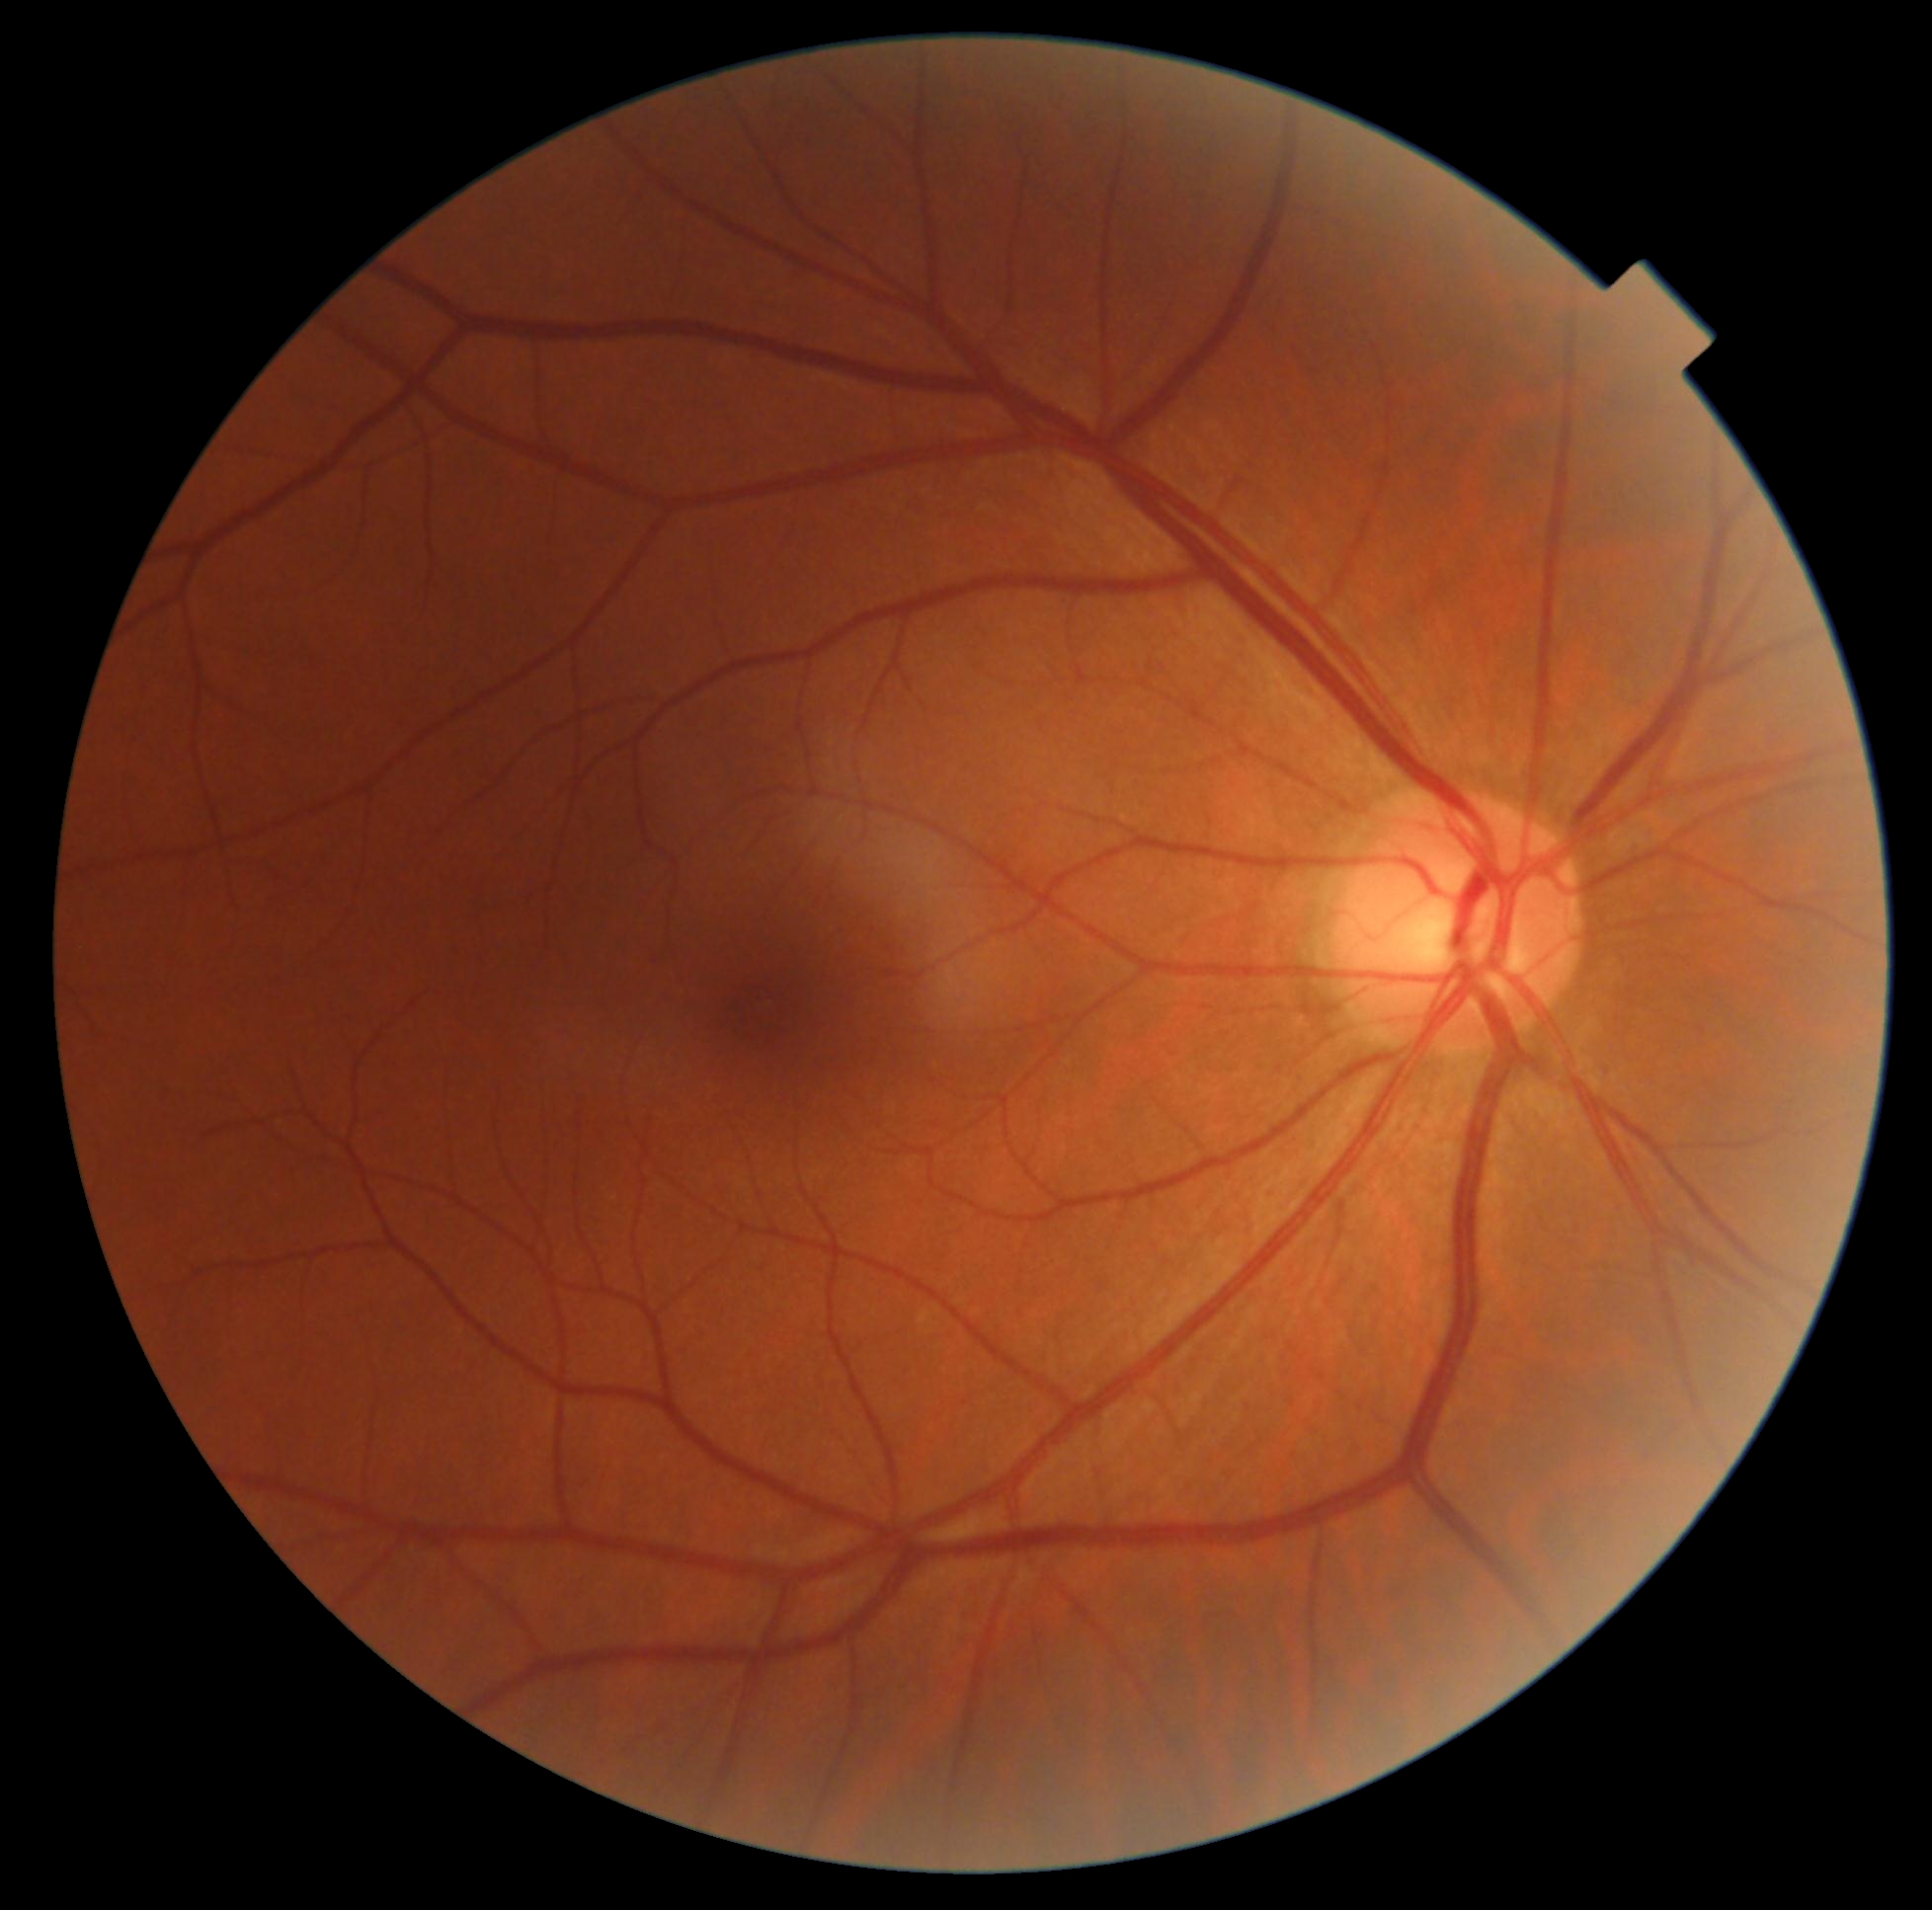

Diabetic retinopathy (DR) is no apparent diabetic retinopathy (grade 0). No signs of diabetic retinopathy.